Color fundus image: 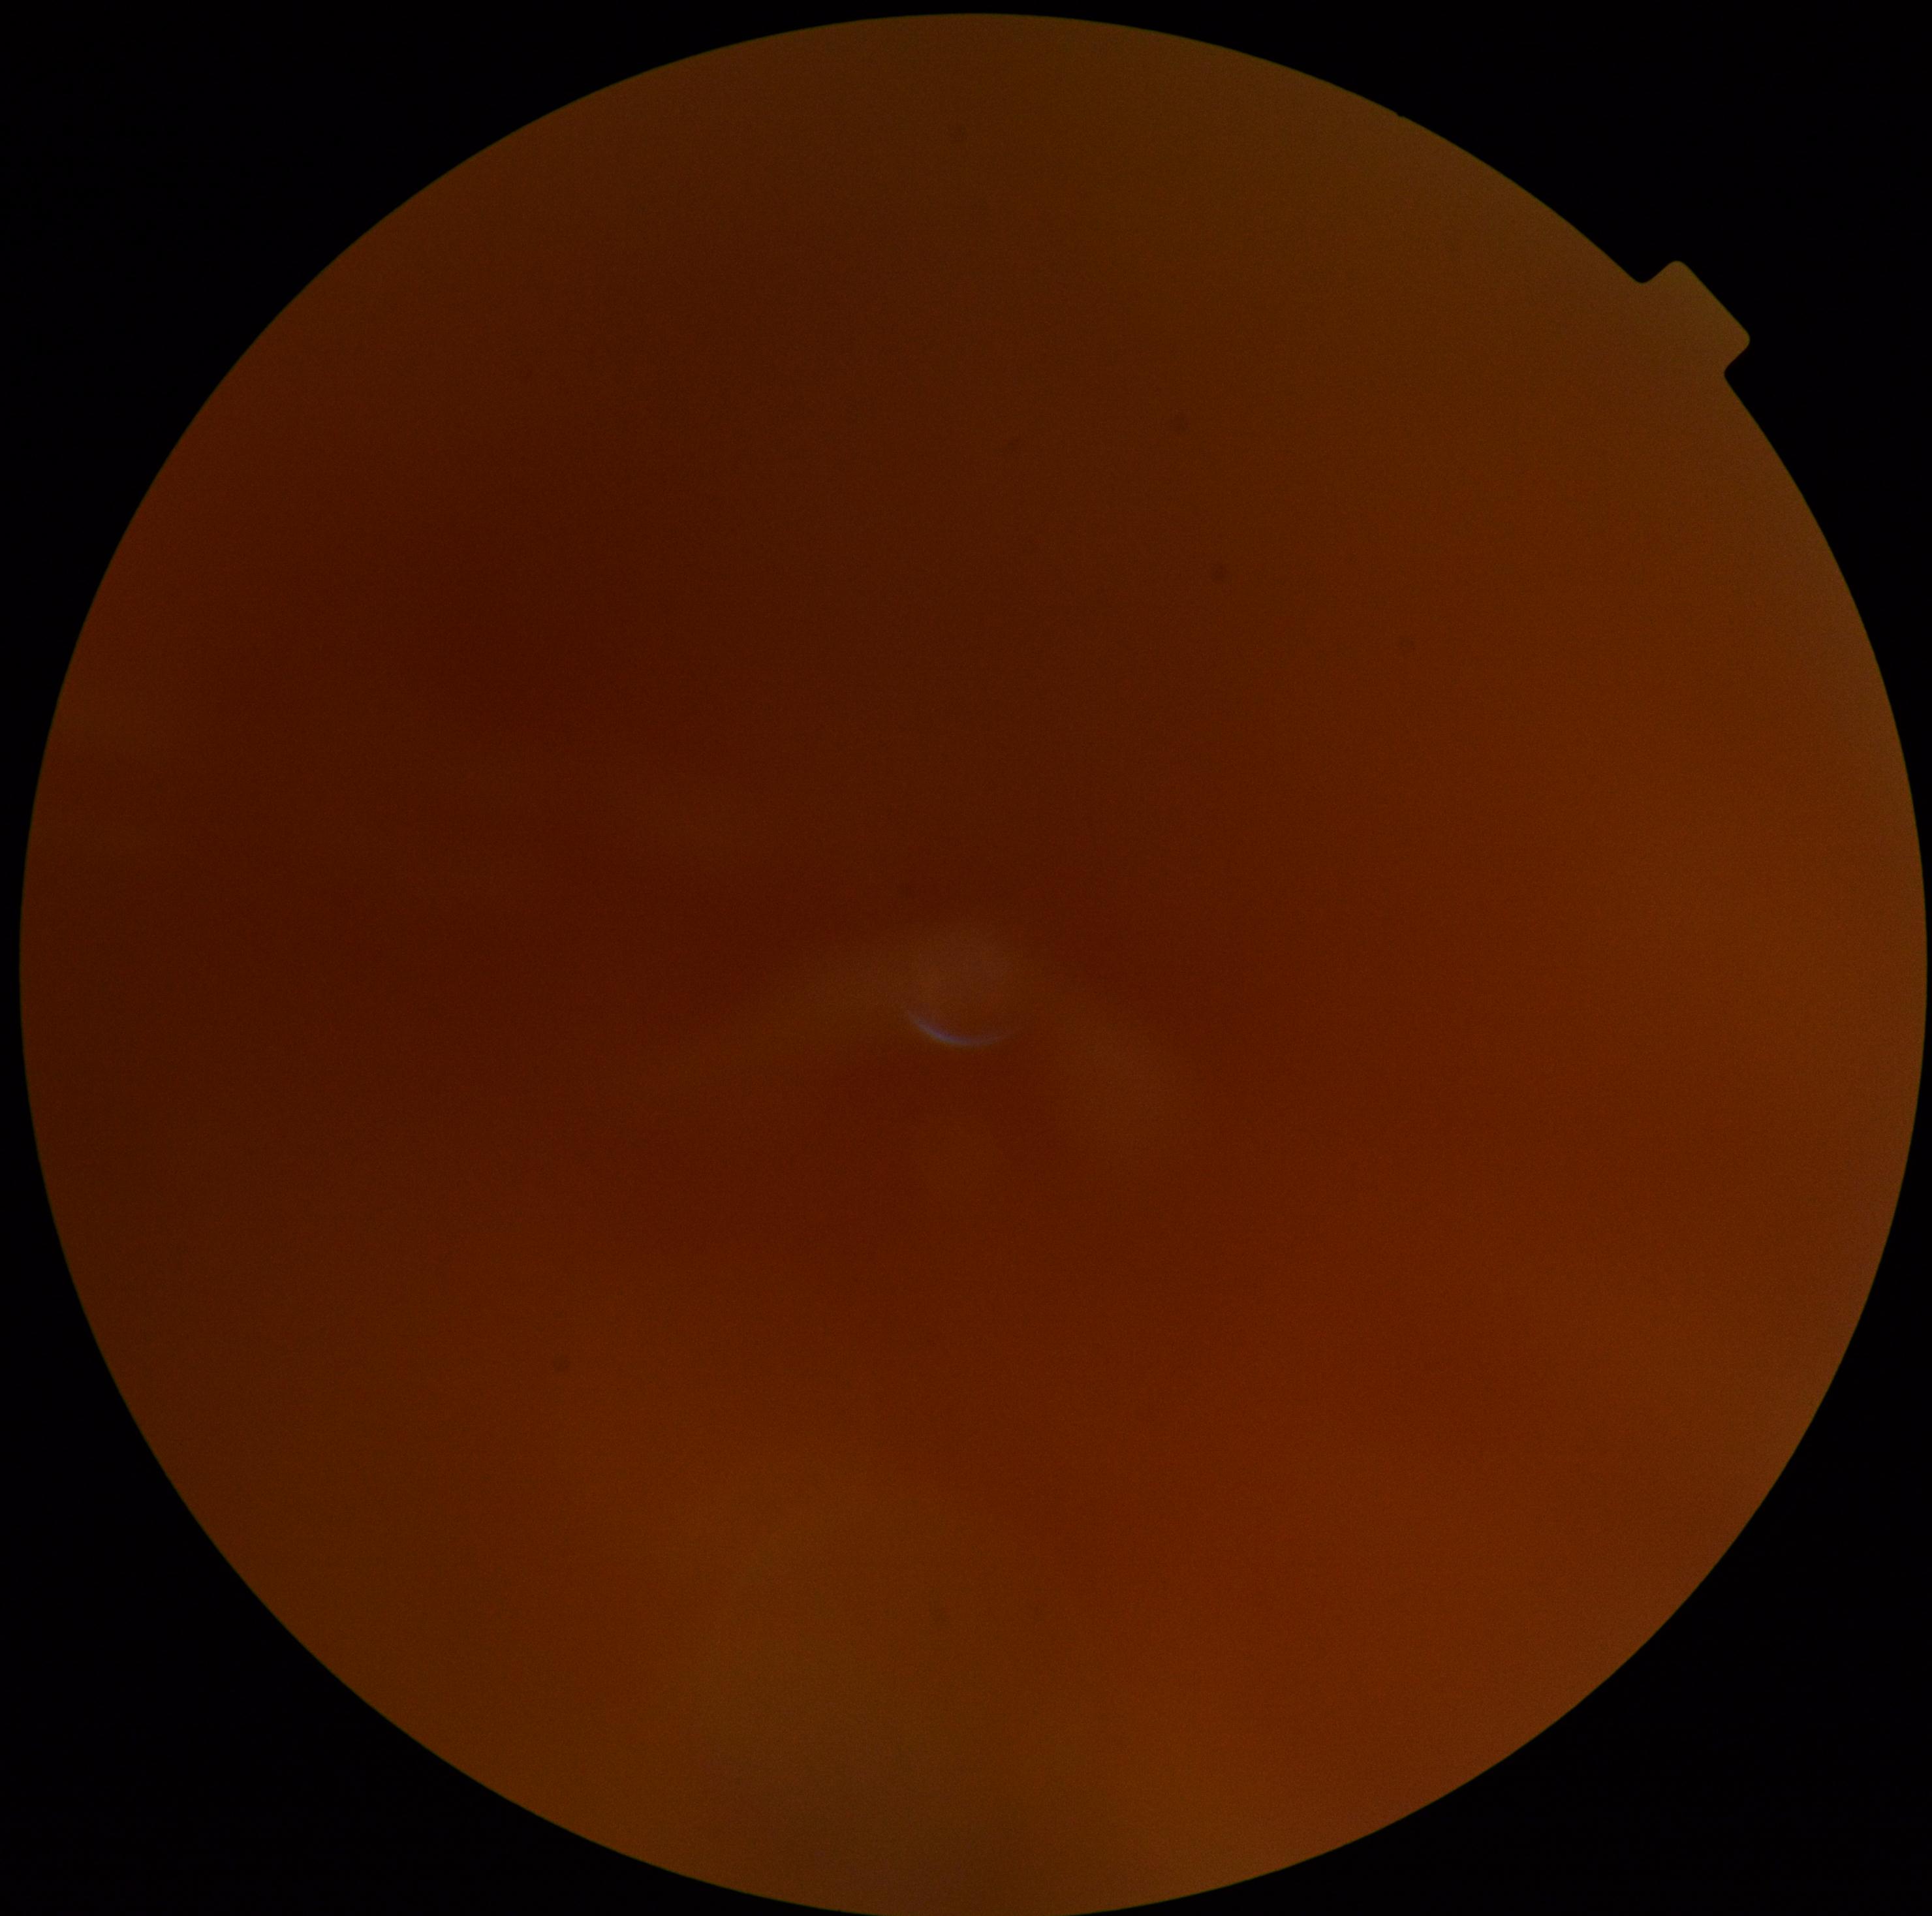
Diabetic retinopathy severity: ungradable.